Infant wide-field retinal image; 130° field of view (Clarity RetCam 3)
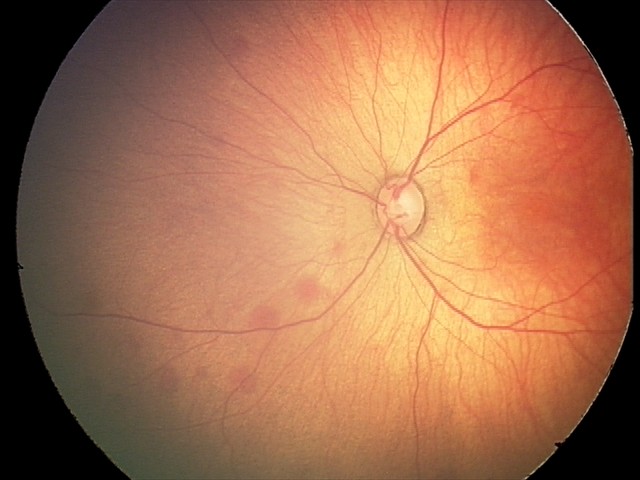

Diagnosis from this screening exam: retinal hemorrhages.